45-degree field of view. 2352x1568px
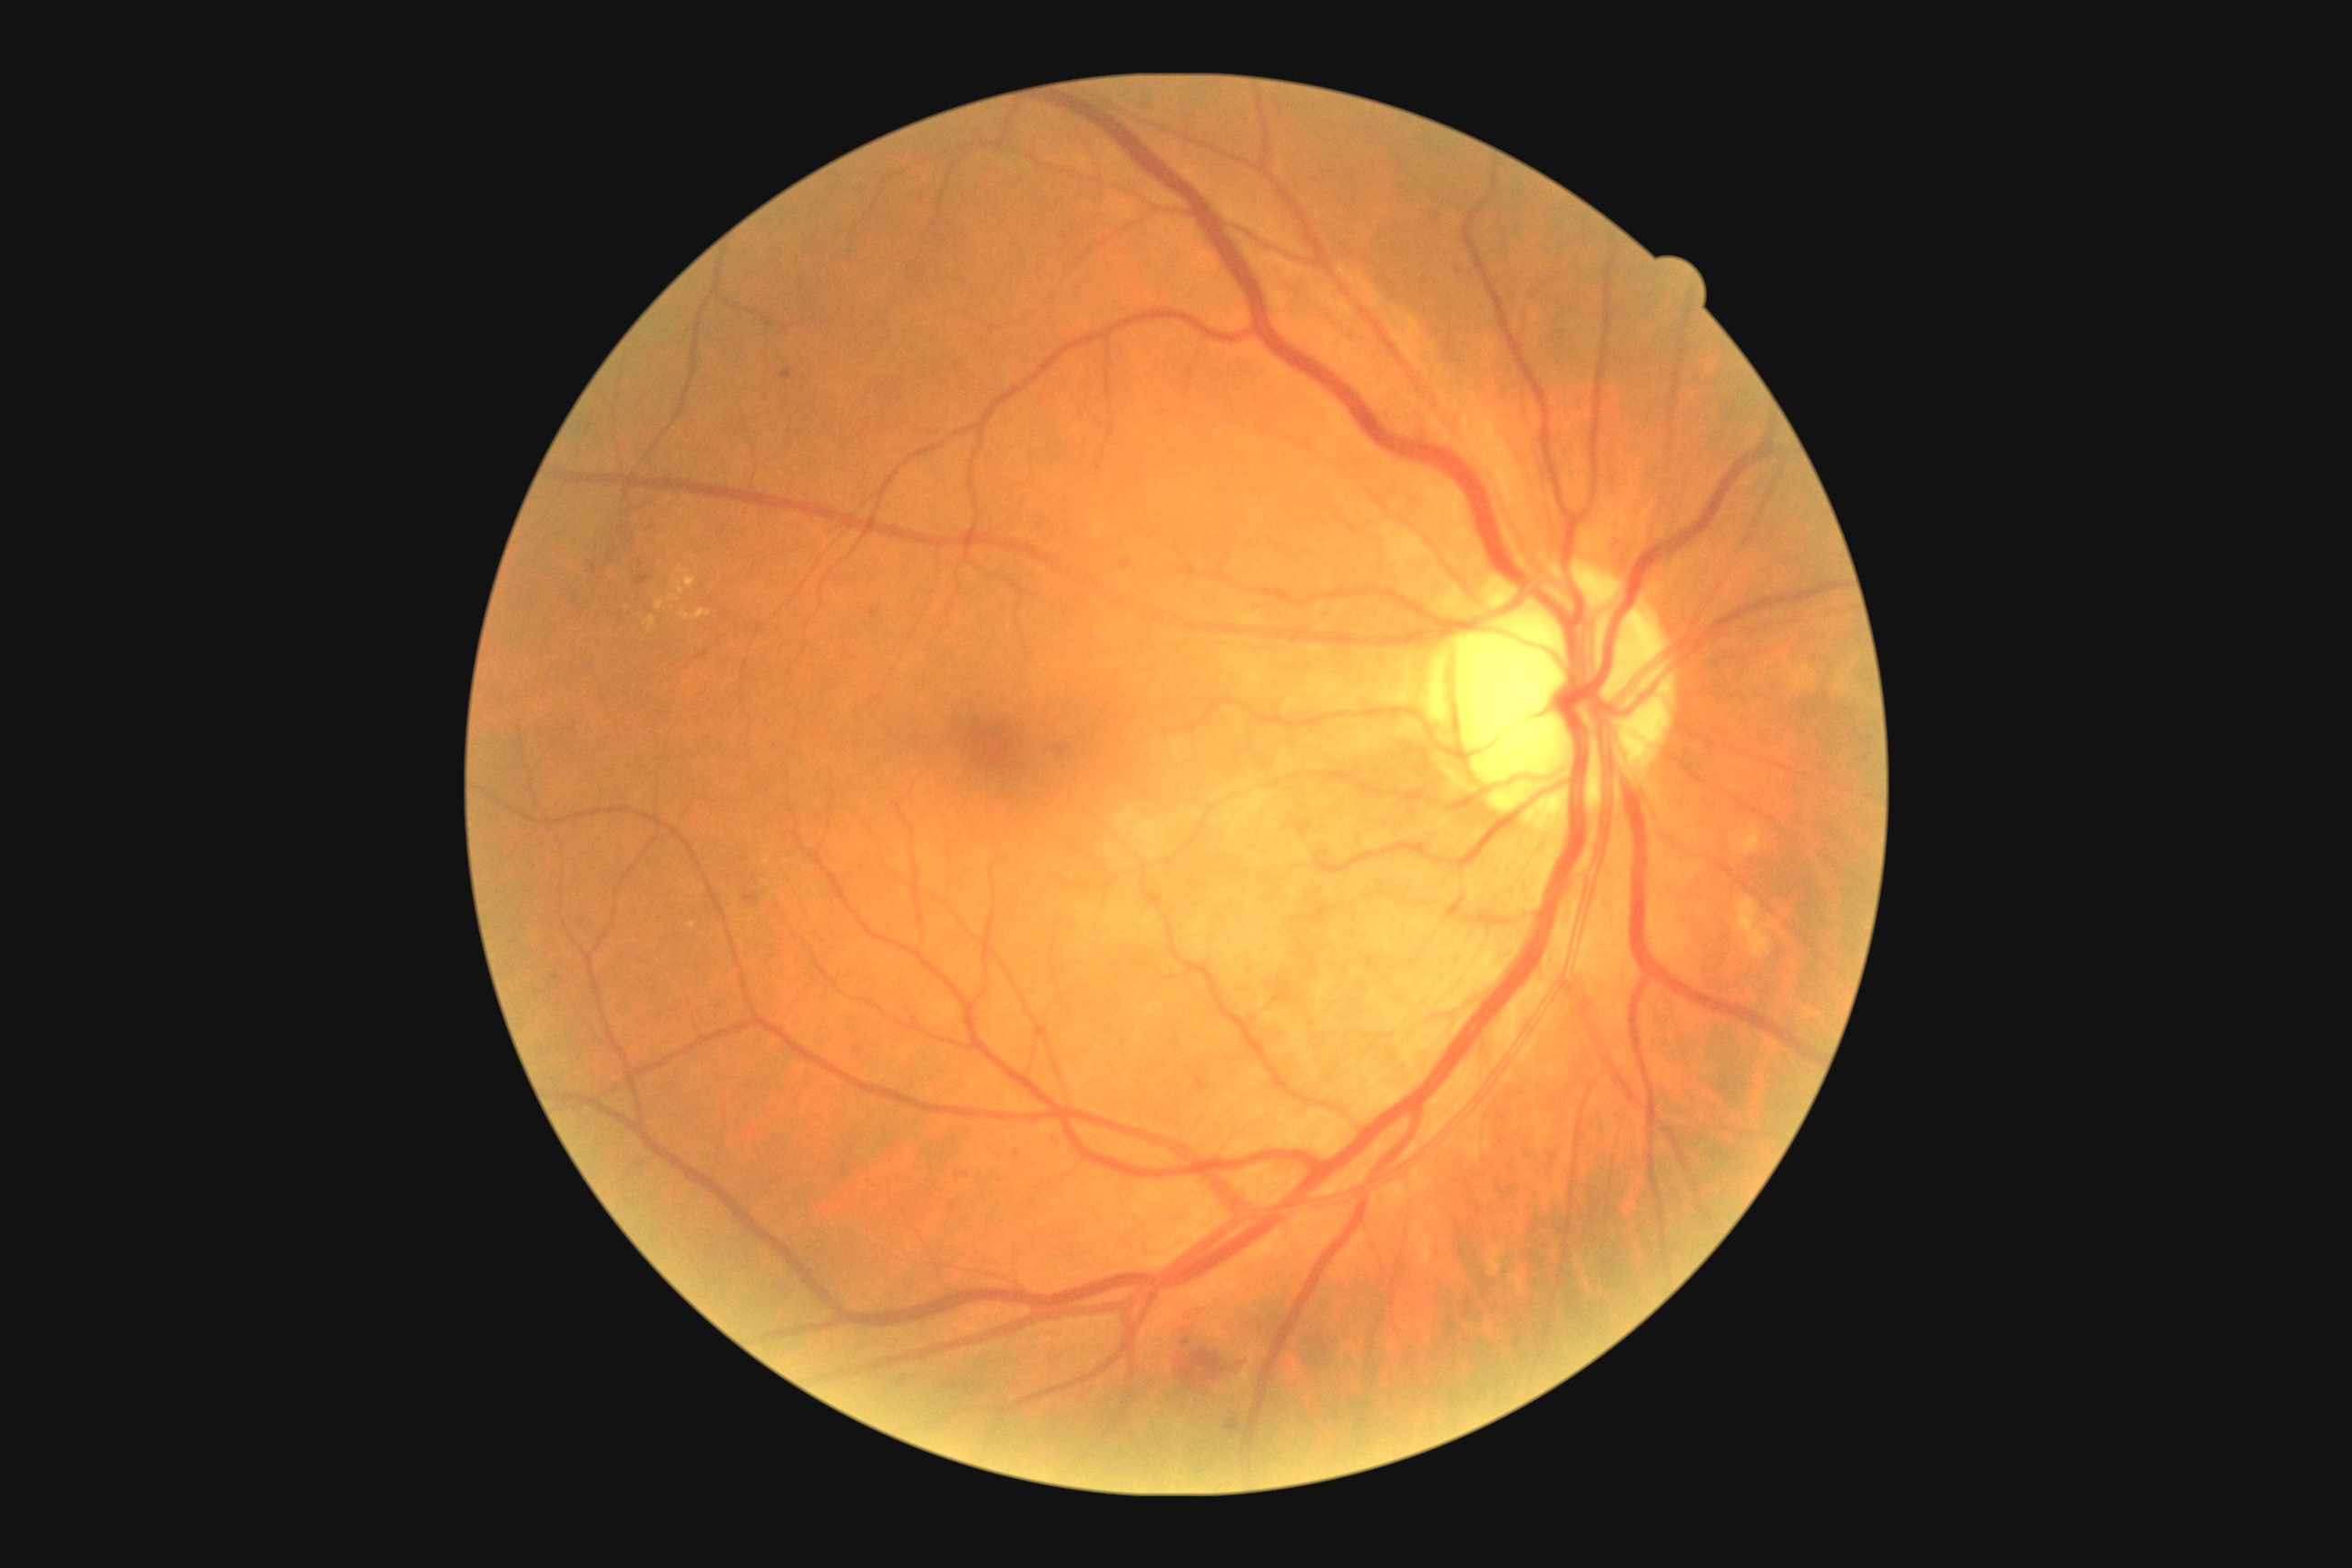
Diabetic retinopathy severity is moderate NPDR (grade 2); non-proliferative diabetic retinopathy
Selected lesions:
hemorrhages (continued): bbox=(1170, 1344, 1239, 1389) | bbox=(1054, 745, 1070, 758) | bbox=(1182, 1340, 1191, 1346) | bbox=(745, 894, 761, 906) | bbox=(1226, 1418, 1240, 1431)
hard exudates: bbox=(681, 609, 710, 622) | bbox=(1736, 825, 1761, 854) | bbox=(669, 567, 696, 603) | bbox=(656, 600, 665, 611) | bbox=(643, 616, 656, 631) | bbox=(1738, 897, 1772, 959)
soft exudates: not present
microaneurysms (continued): bbox=(636, 574, 651, 587) | bbox=(1195, 1077, 1208, 1093) | bbox=(1121, 560, 1130, 569) | bbox=(956, 1173, 970, 1179) | bbox=(841, 1173, 850, 1179) | bbox=(1048, 1137, 1064, 1150) | bbox=(1014, 1150, 1021, 1159) | bbox=(589, 562, 596, 574) | bbox=(870, 609, 881, 618) | bbox=(901, 1378, 906, 1386) | bbox=(779, 368, 792, 380)
Small microaneurysms near pt(642, 1165) | pt(651, 528) | pt(621, 531) | pt(576, 600) | pt(612, 554) | pt(555, 978) | pt(631, 541)